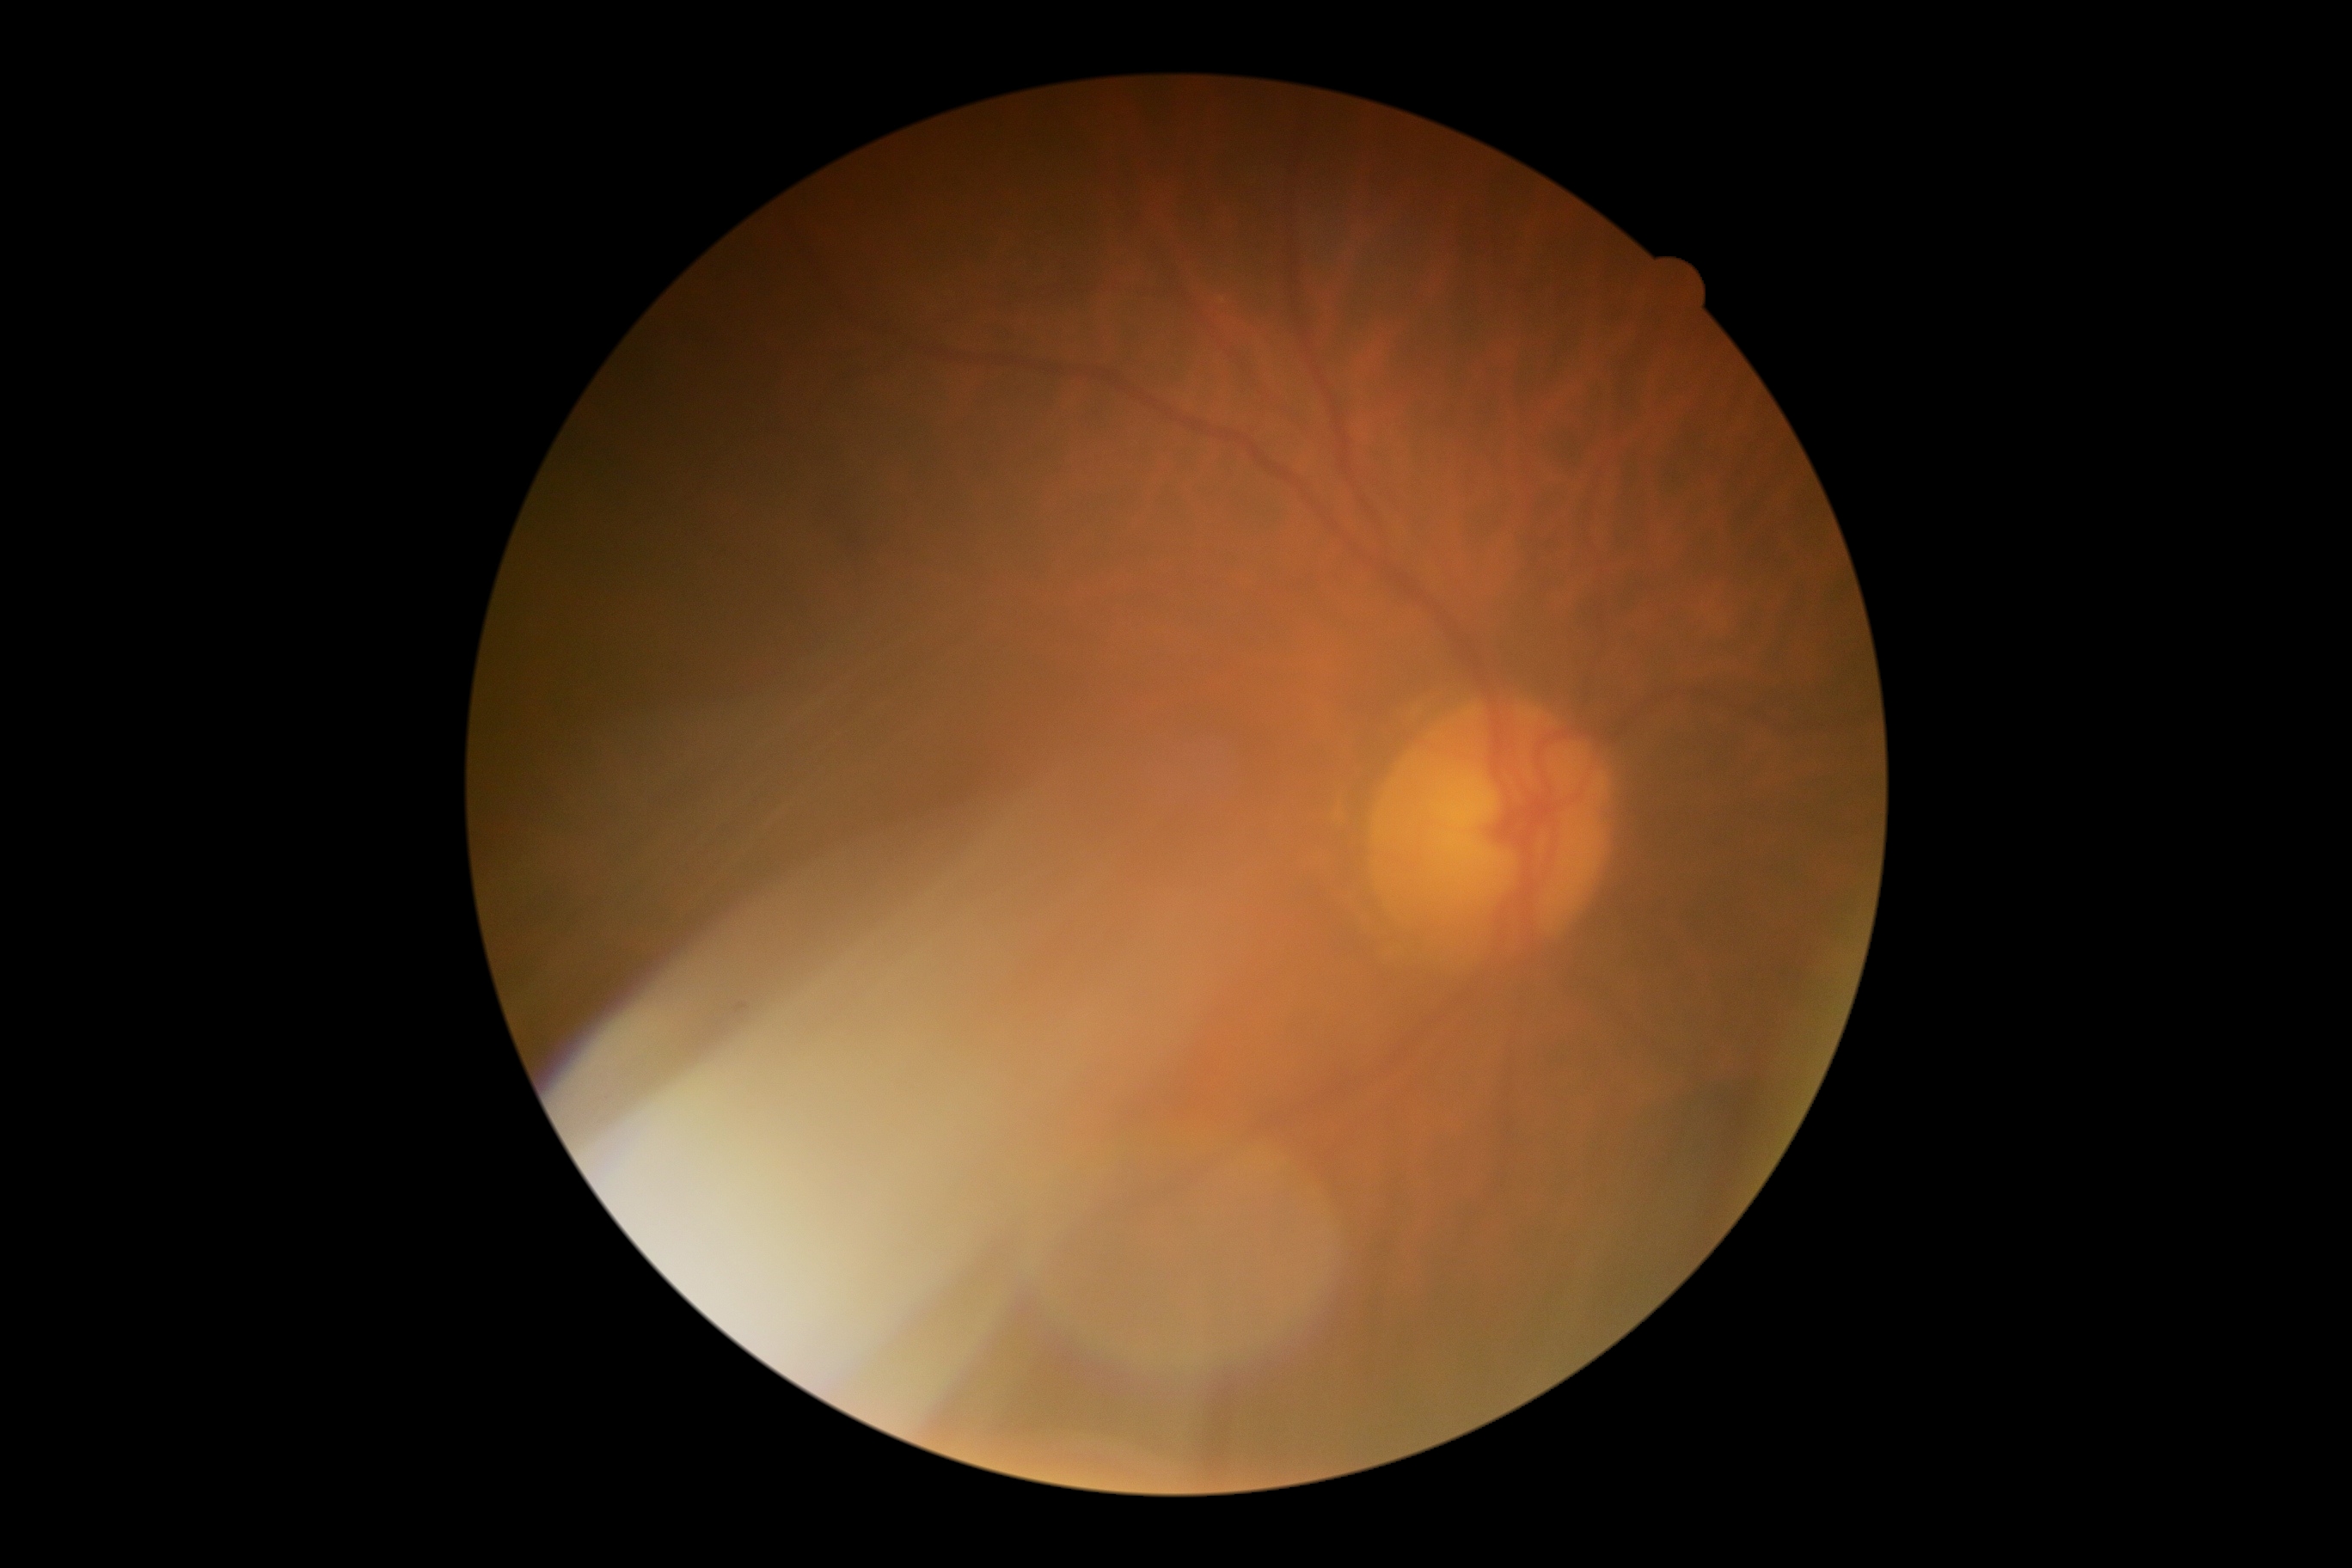

No DR findings. DR is grade 0 (no apparent retinopathy).